412 by 310 pixels — 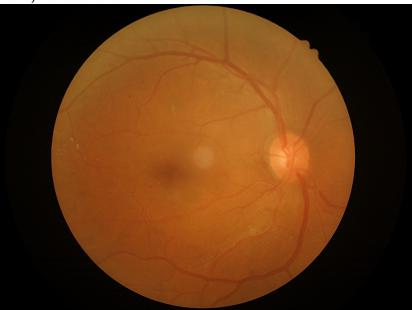
No over- or under-exposure. Image quality is adequate for diagnostic use. Adequate contrast for distinguishing structures.